2212x1659px. FOV: 45 degrees: 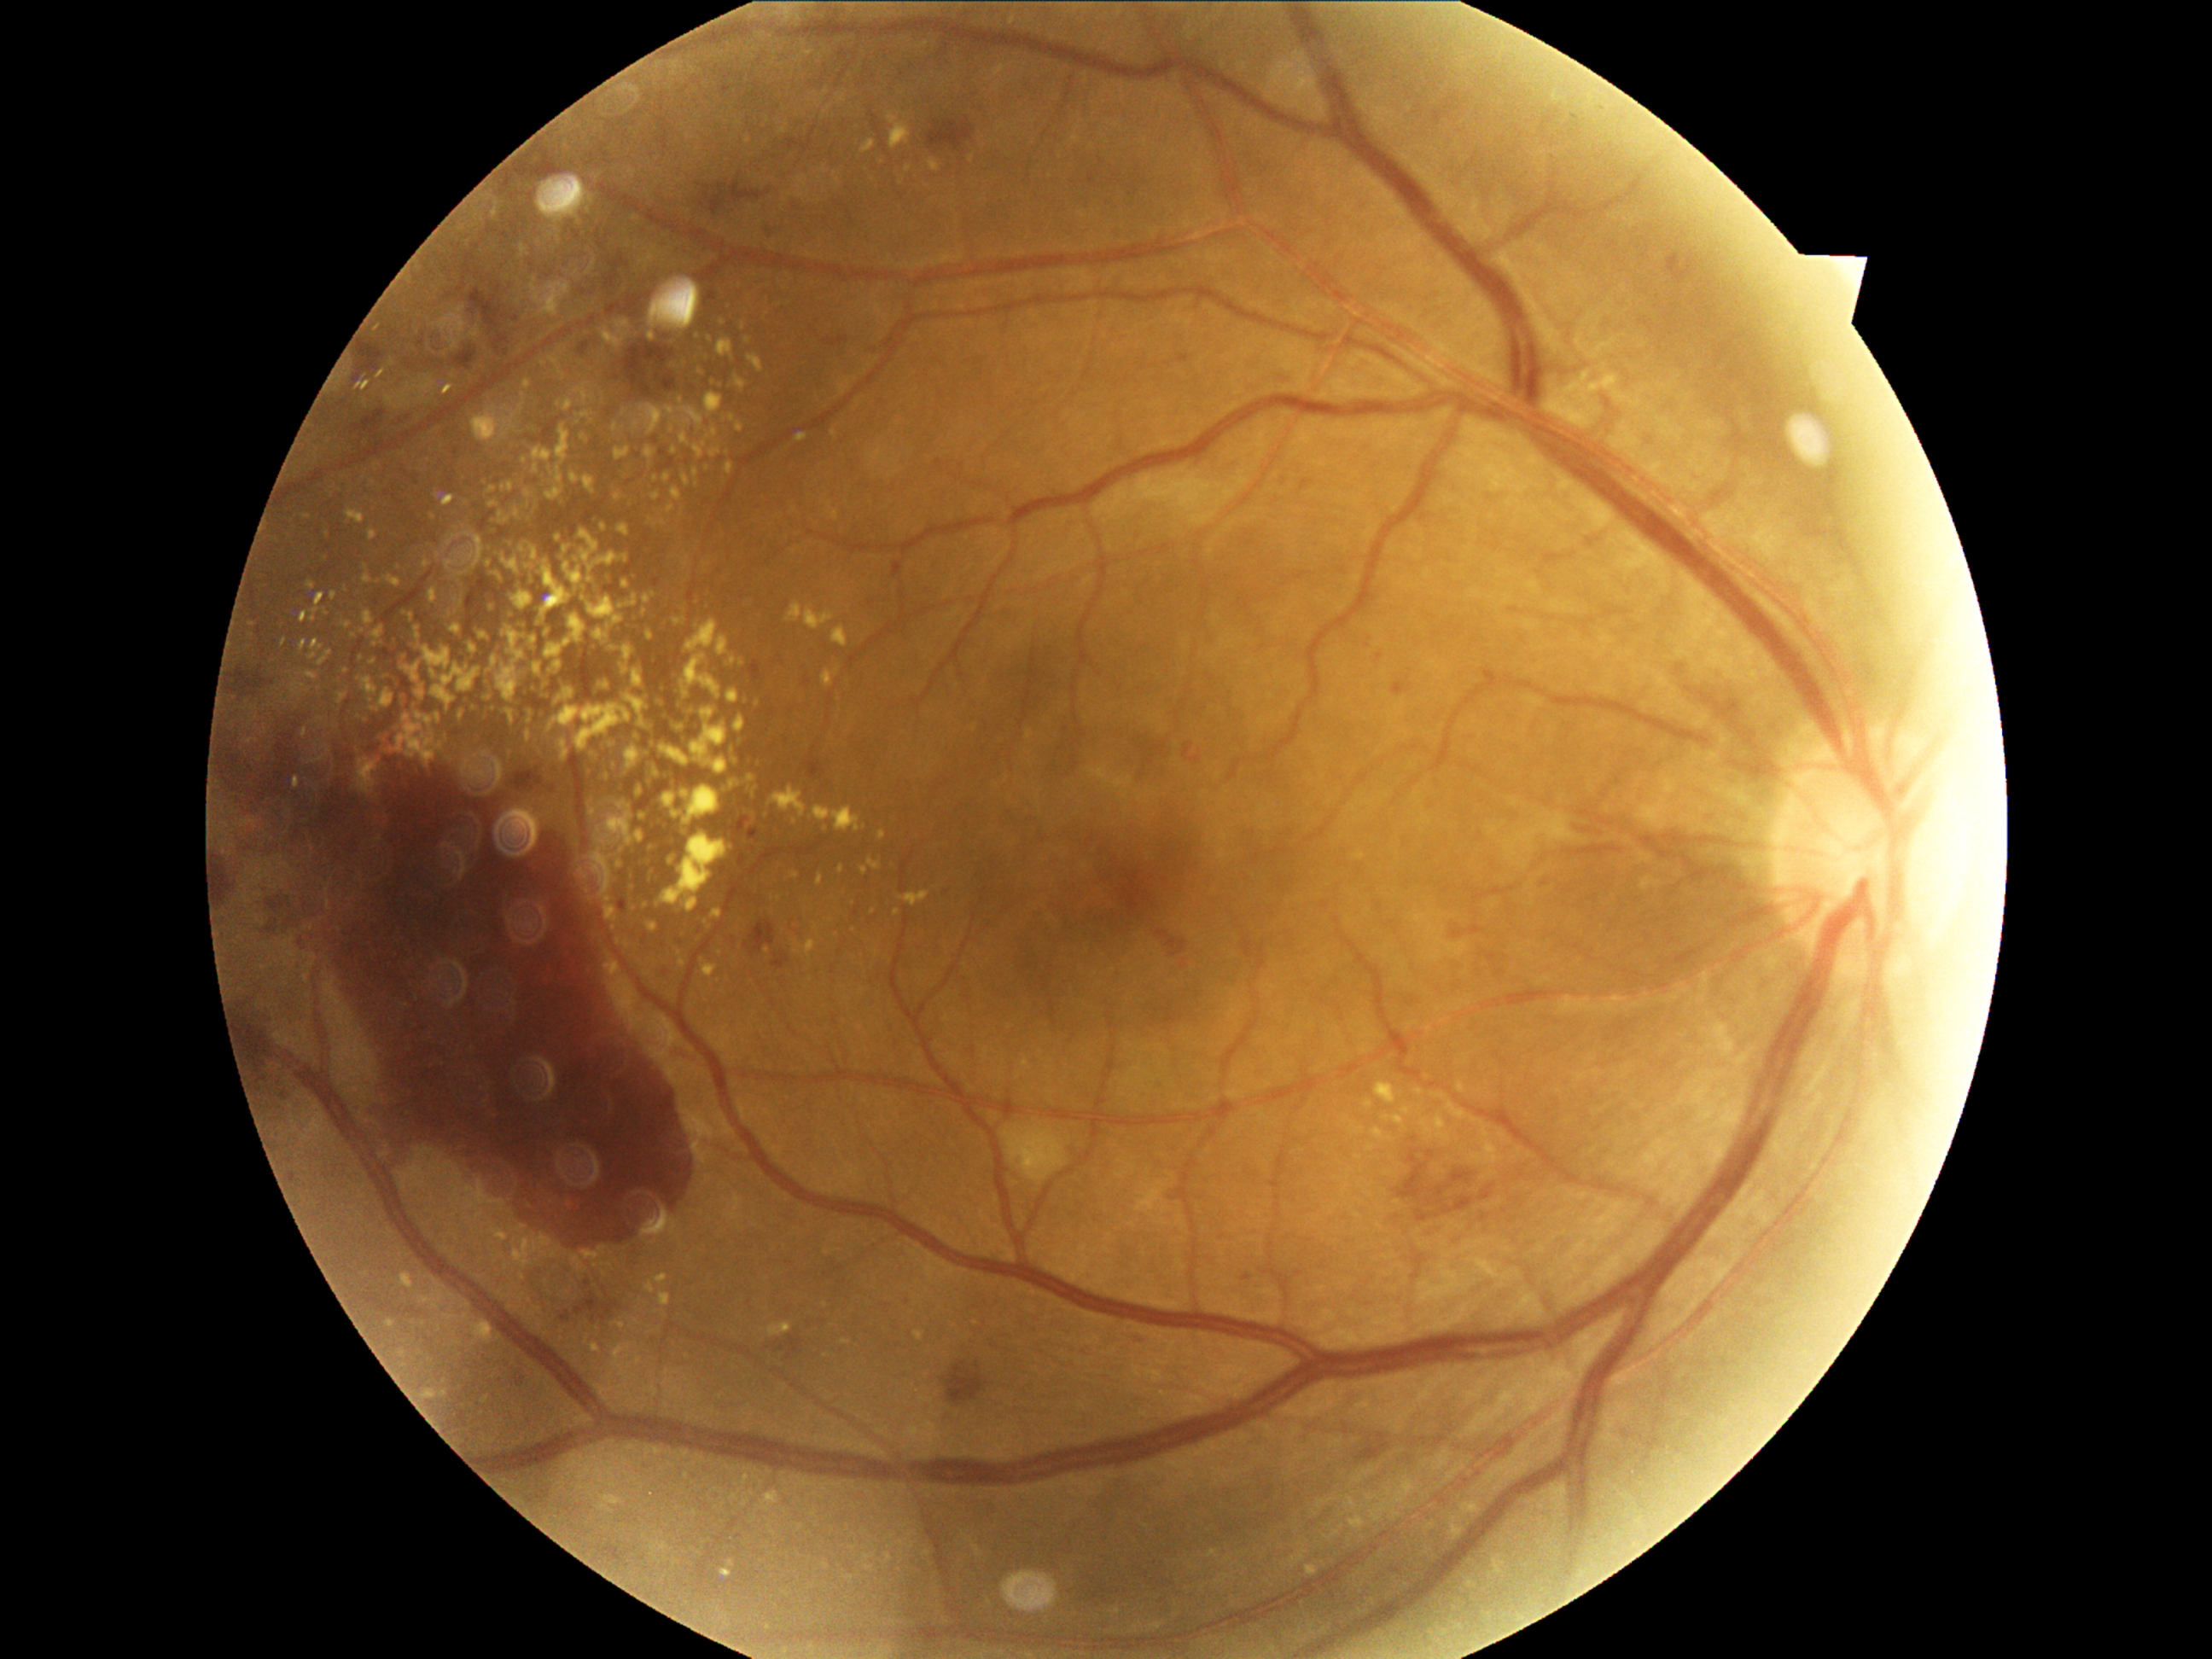
Diabetic retinopathy (DR): grade 4 (PDR). Hard exudates (EXs) include lesions at rect(566, 400, 574, 410) | rect(619, 525, 631, 537) | rect(760, 817, 771, 824) | rect(714, 380, 723, 388) | rect(515, 1235, 554, 1267) | rect(694, 480, 699, 489) | rect(892, 124, 911, 149) | rect(648, 841, 655, 849) | rect(347, 511, 364, 523) | rect(769, 1324, 793, 1336) | rect(508, 711, 516, 725). Small EXs approximately at 865/871 | 752/342 | 699/960 | 740/744 | 584/600 | 313/658 | 631/619 | 559/539.